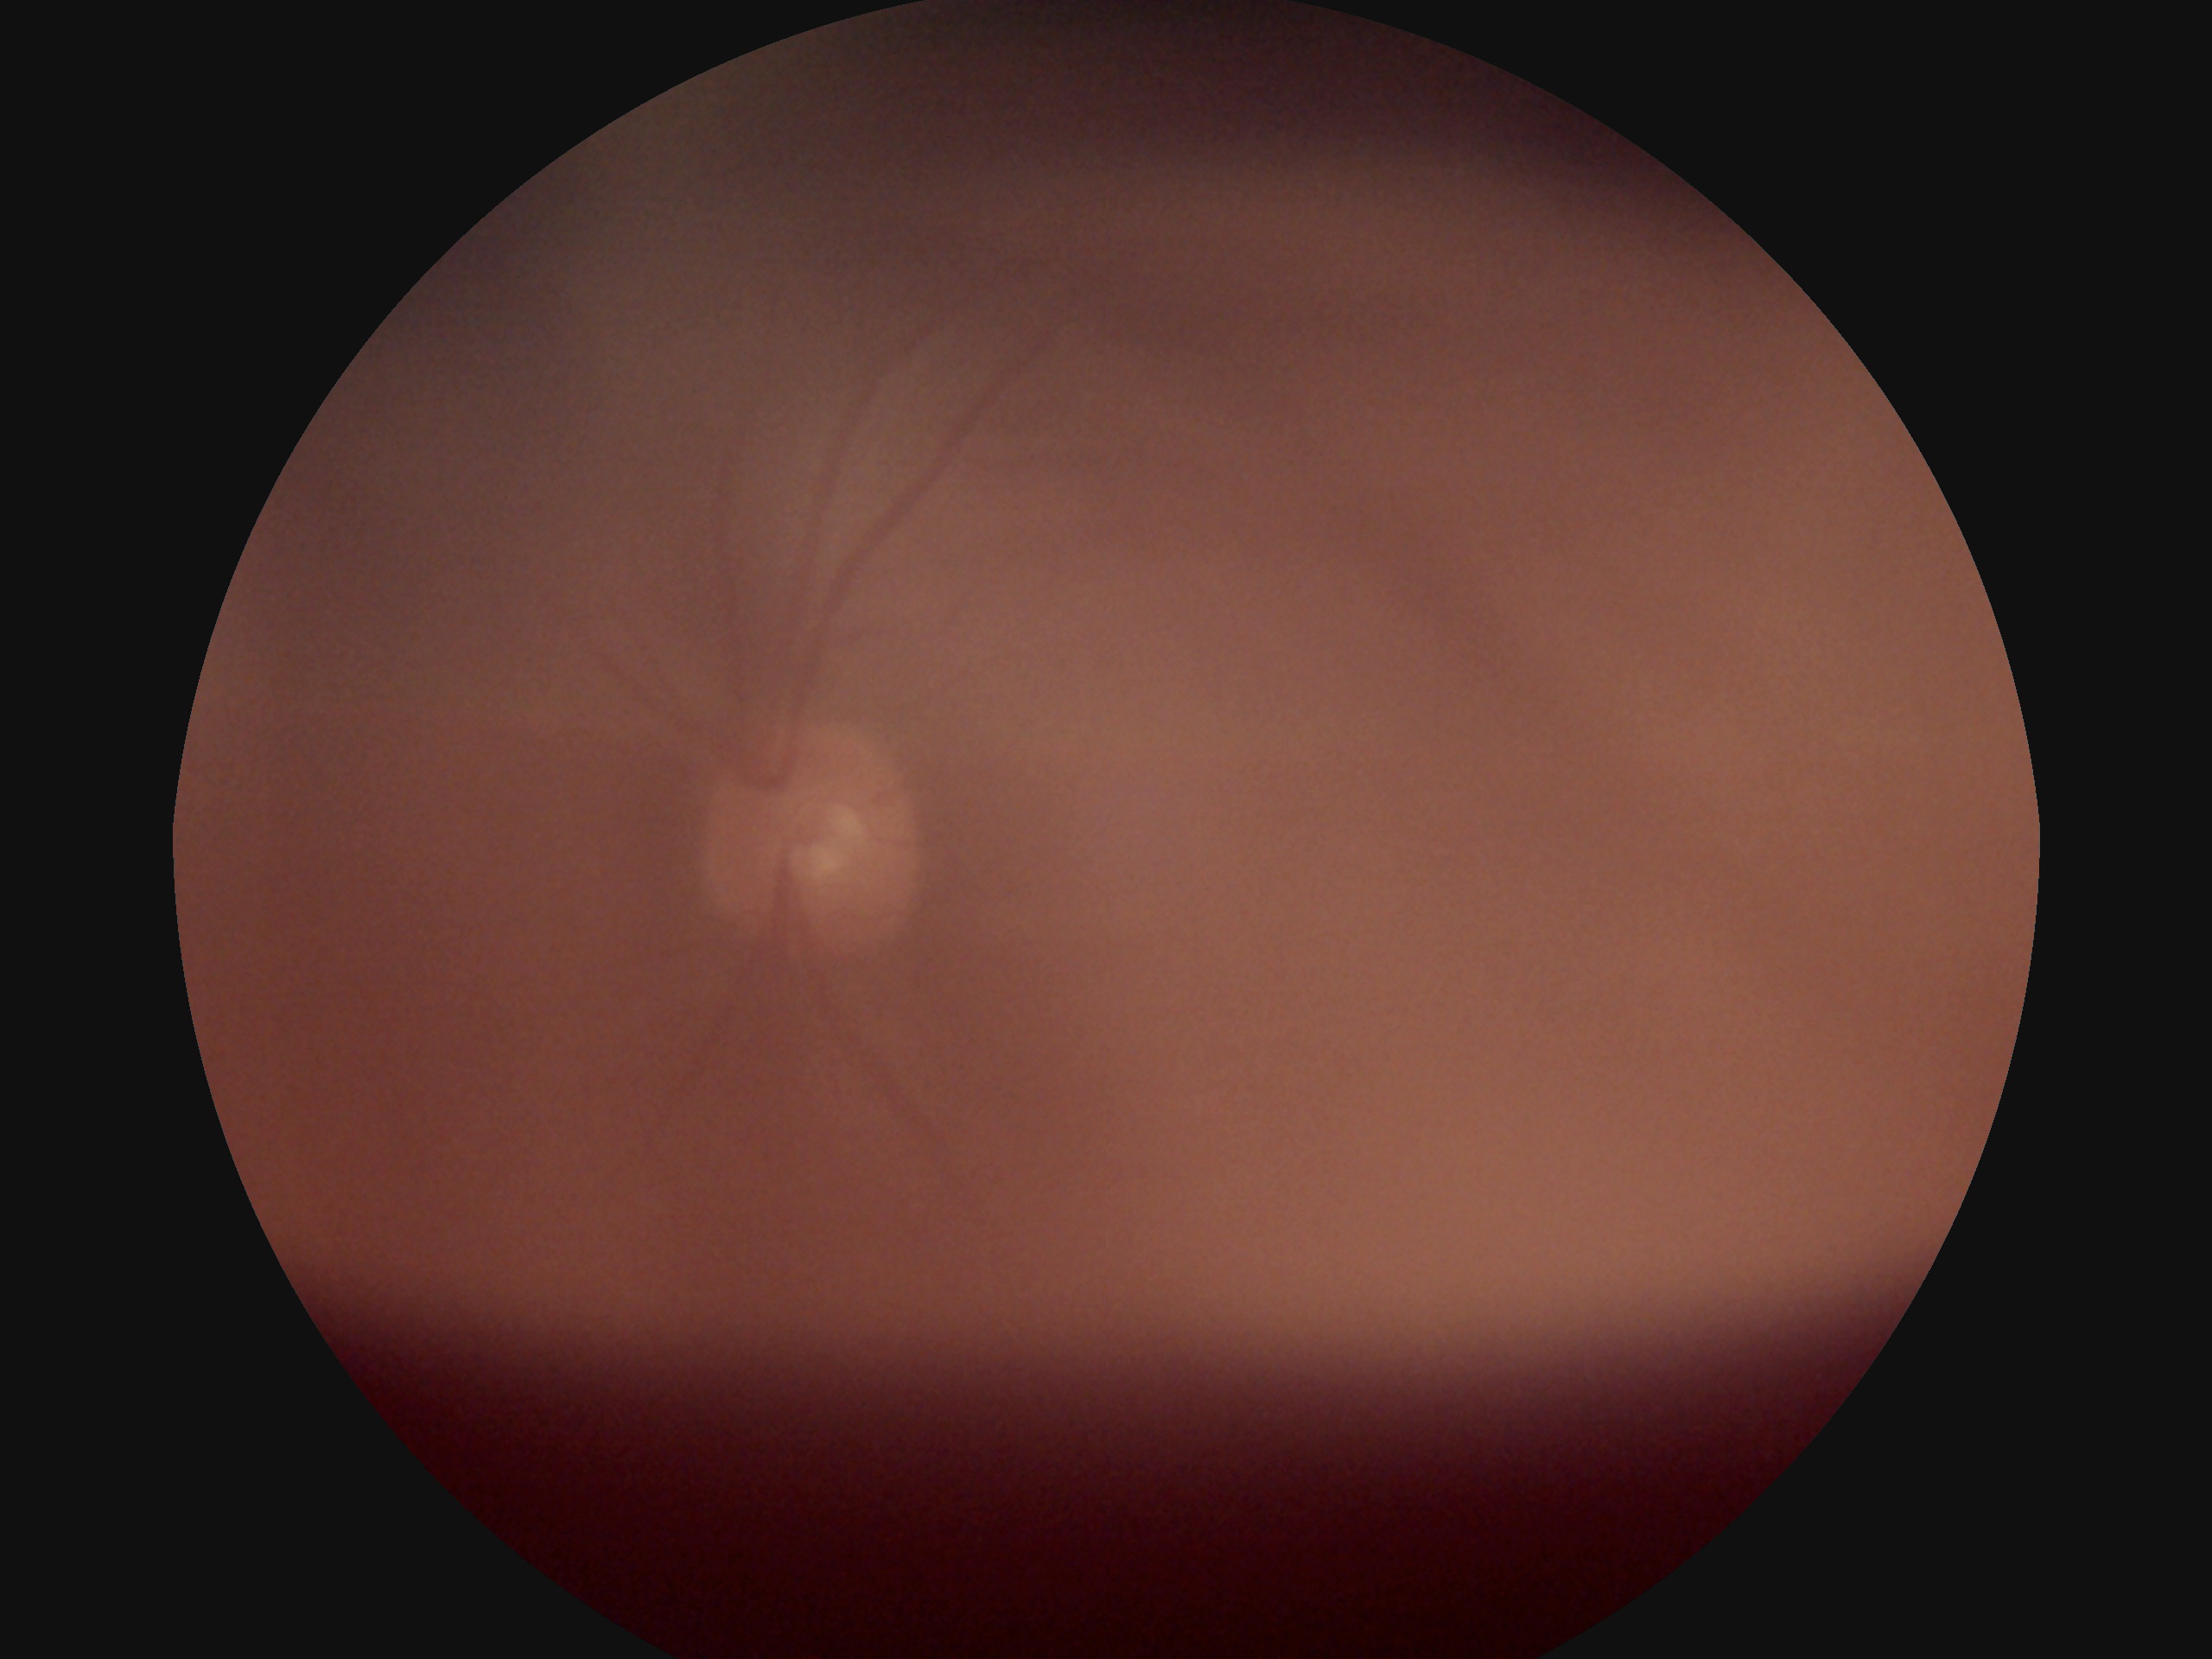
image quality: too poor for DR grading | DR severity: ungradable.